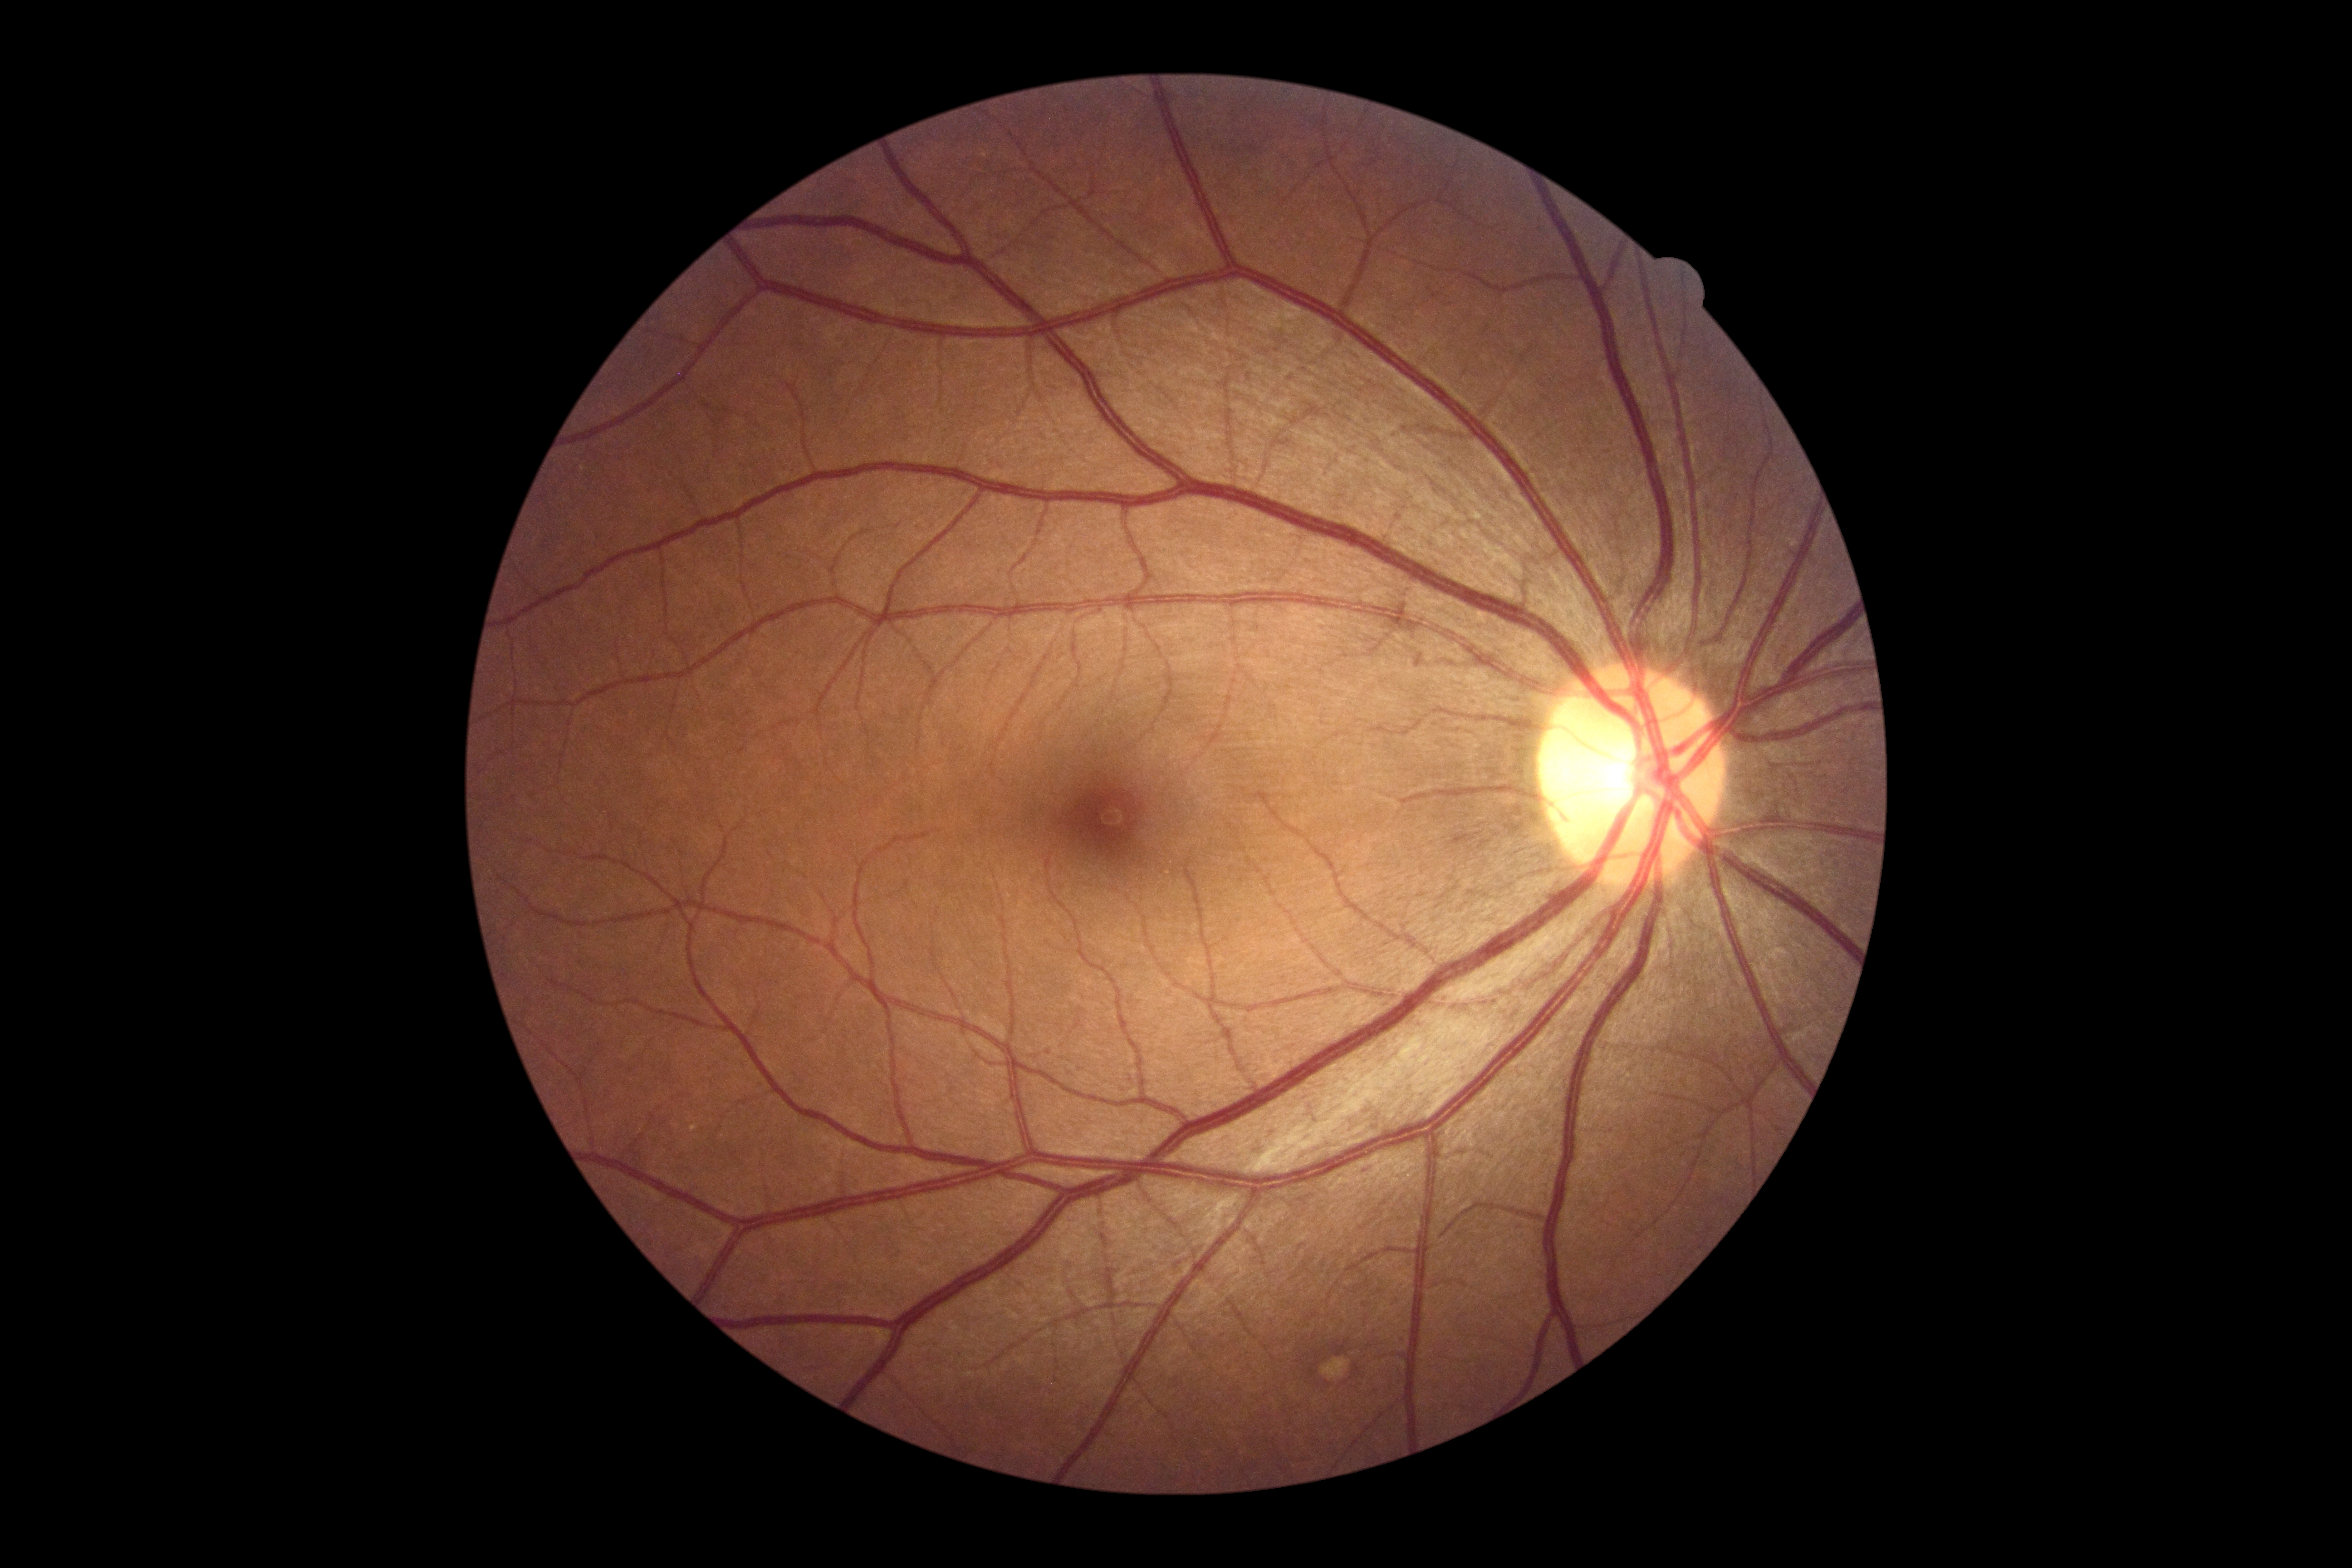 – diabetic retinopathy (DR): no apparent diabetic retinopathy (grade 0)